1240x1240; wide-field fundus photograph of an infant.
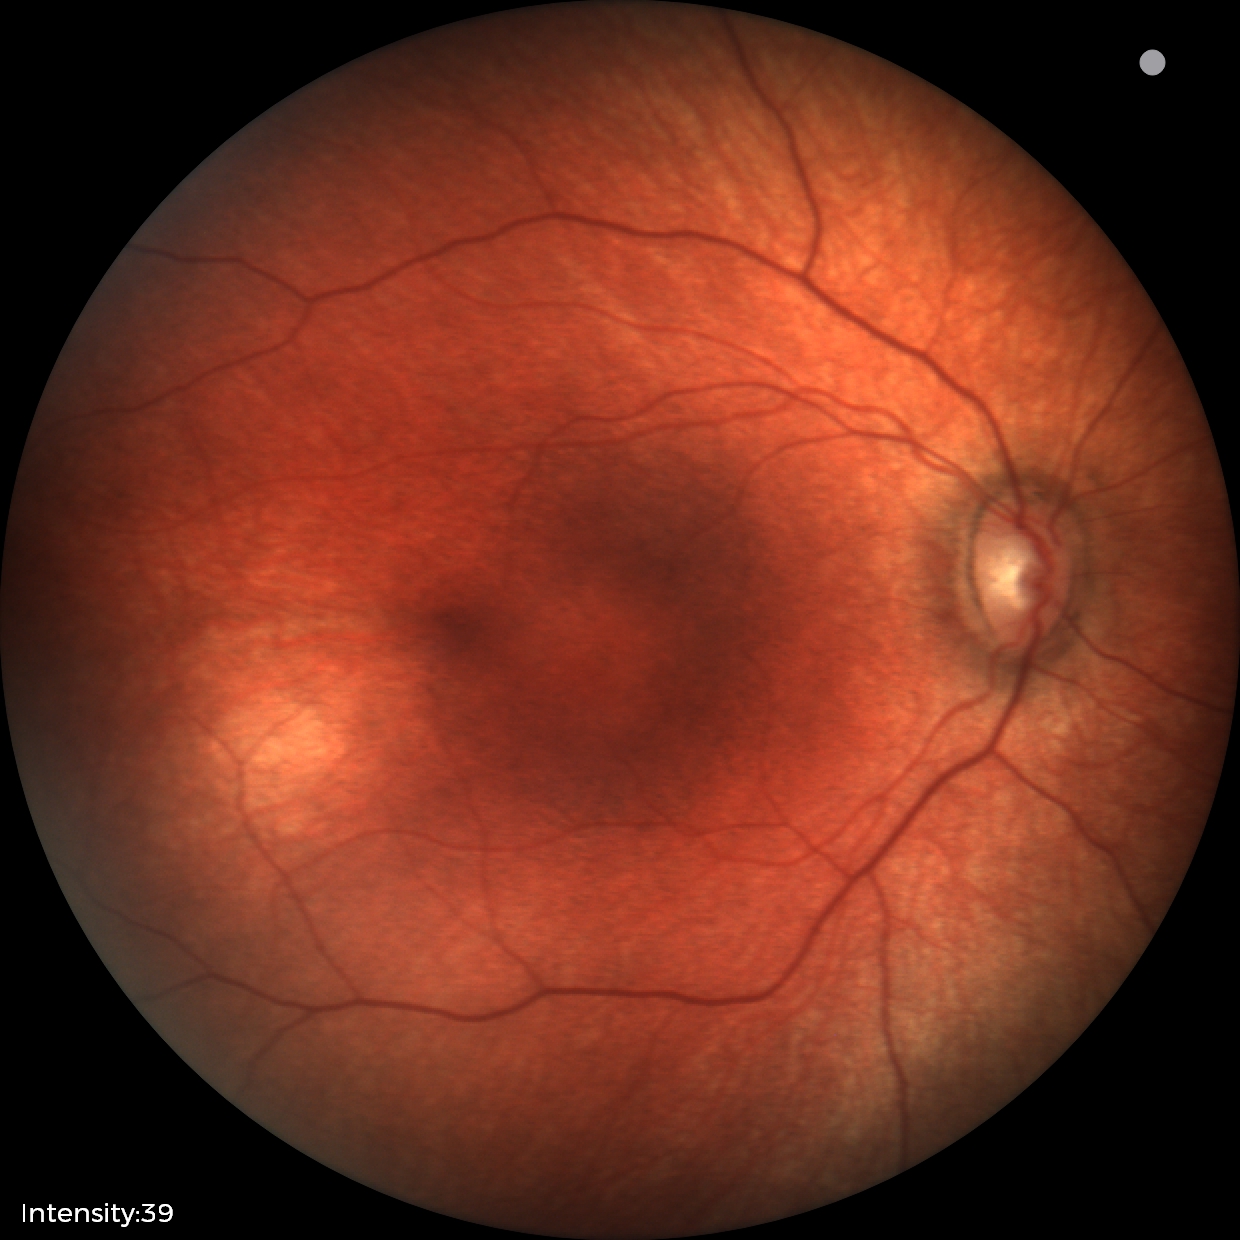
Q: What was the screening finding?
A: physiological retinal finding